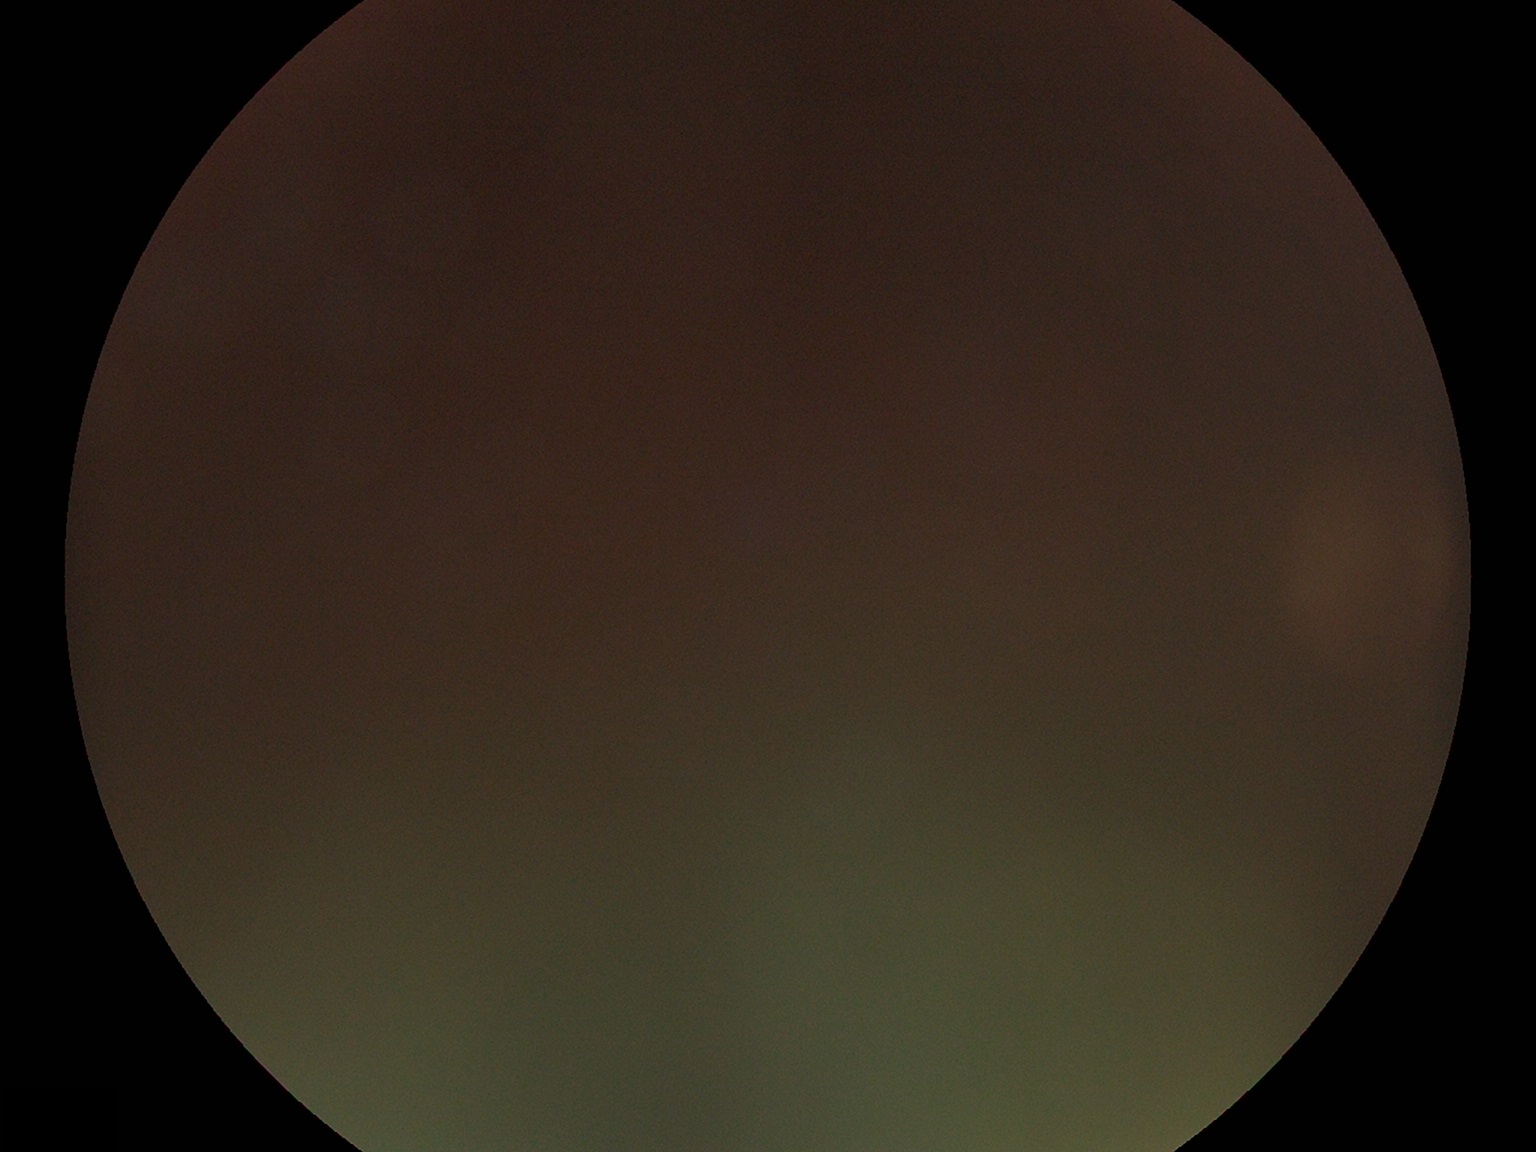 image quality = below grading threshold; DR severity = ungradable.